RetCam wide-field infant fundus image · 1440 by 1080 pixels:
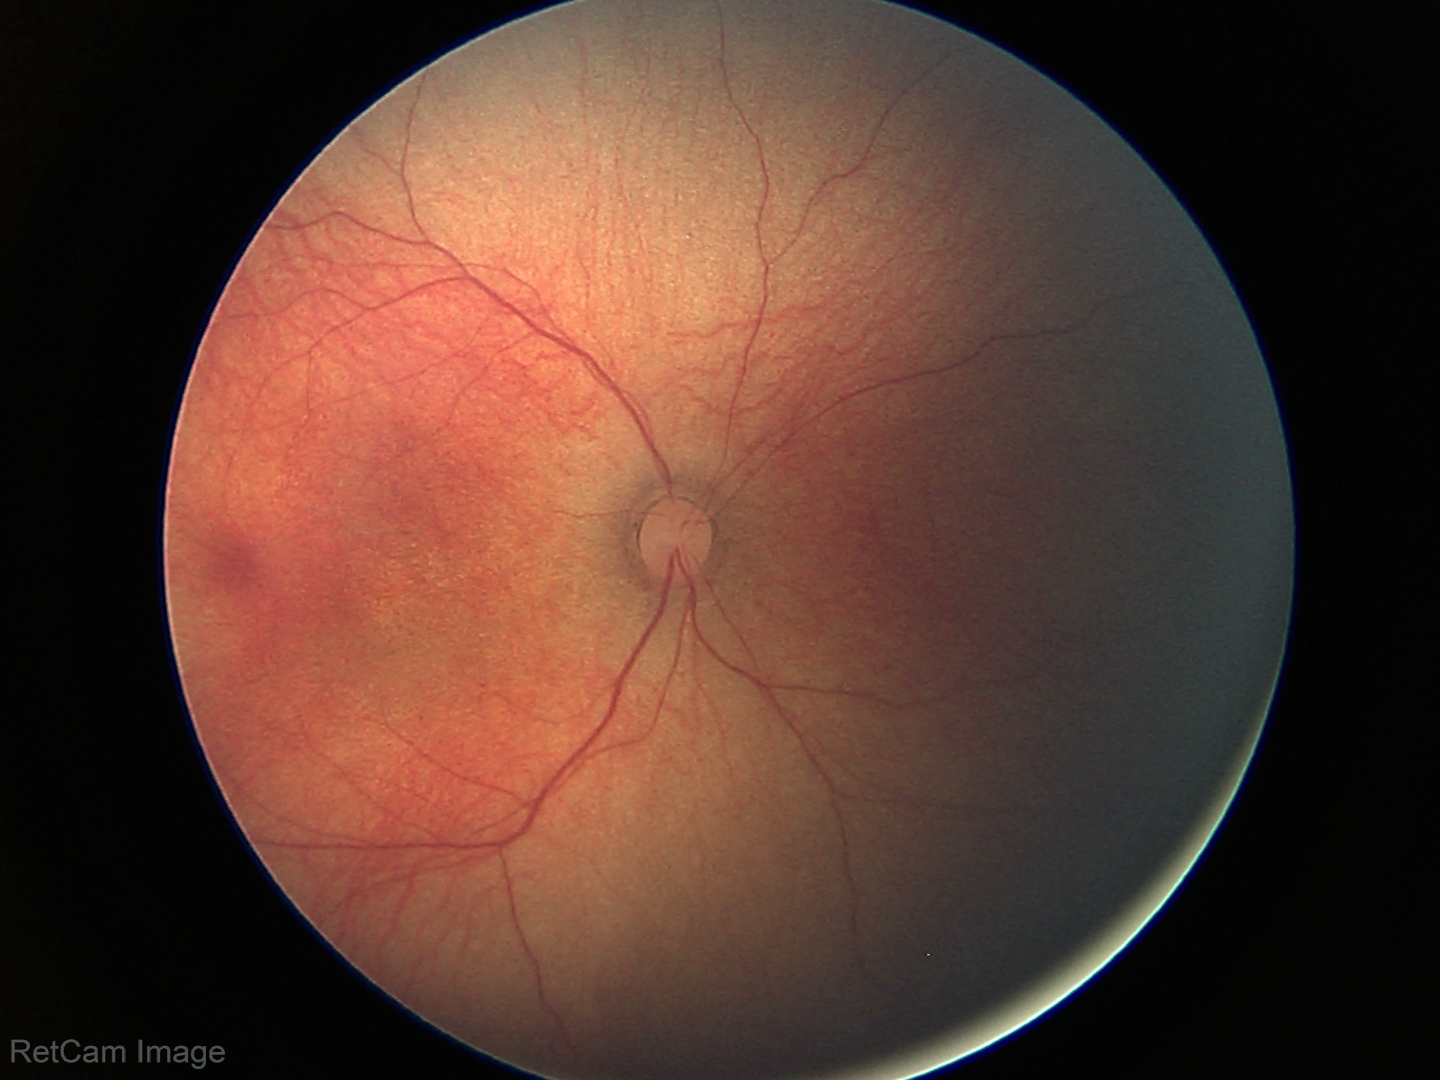

Normal screening examination.